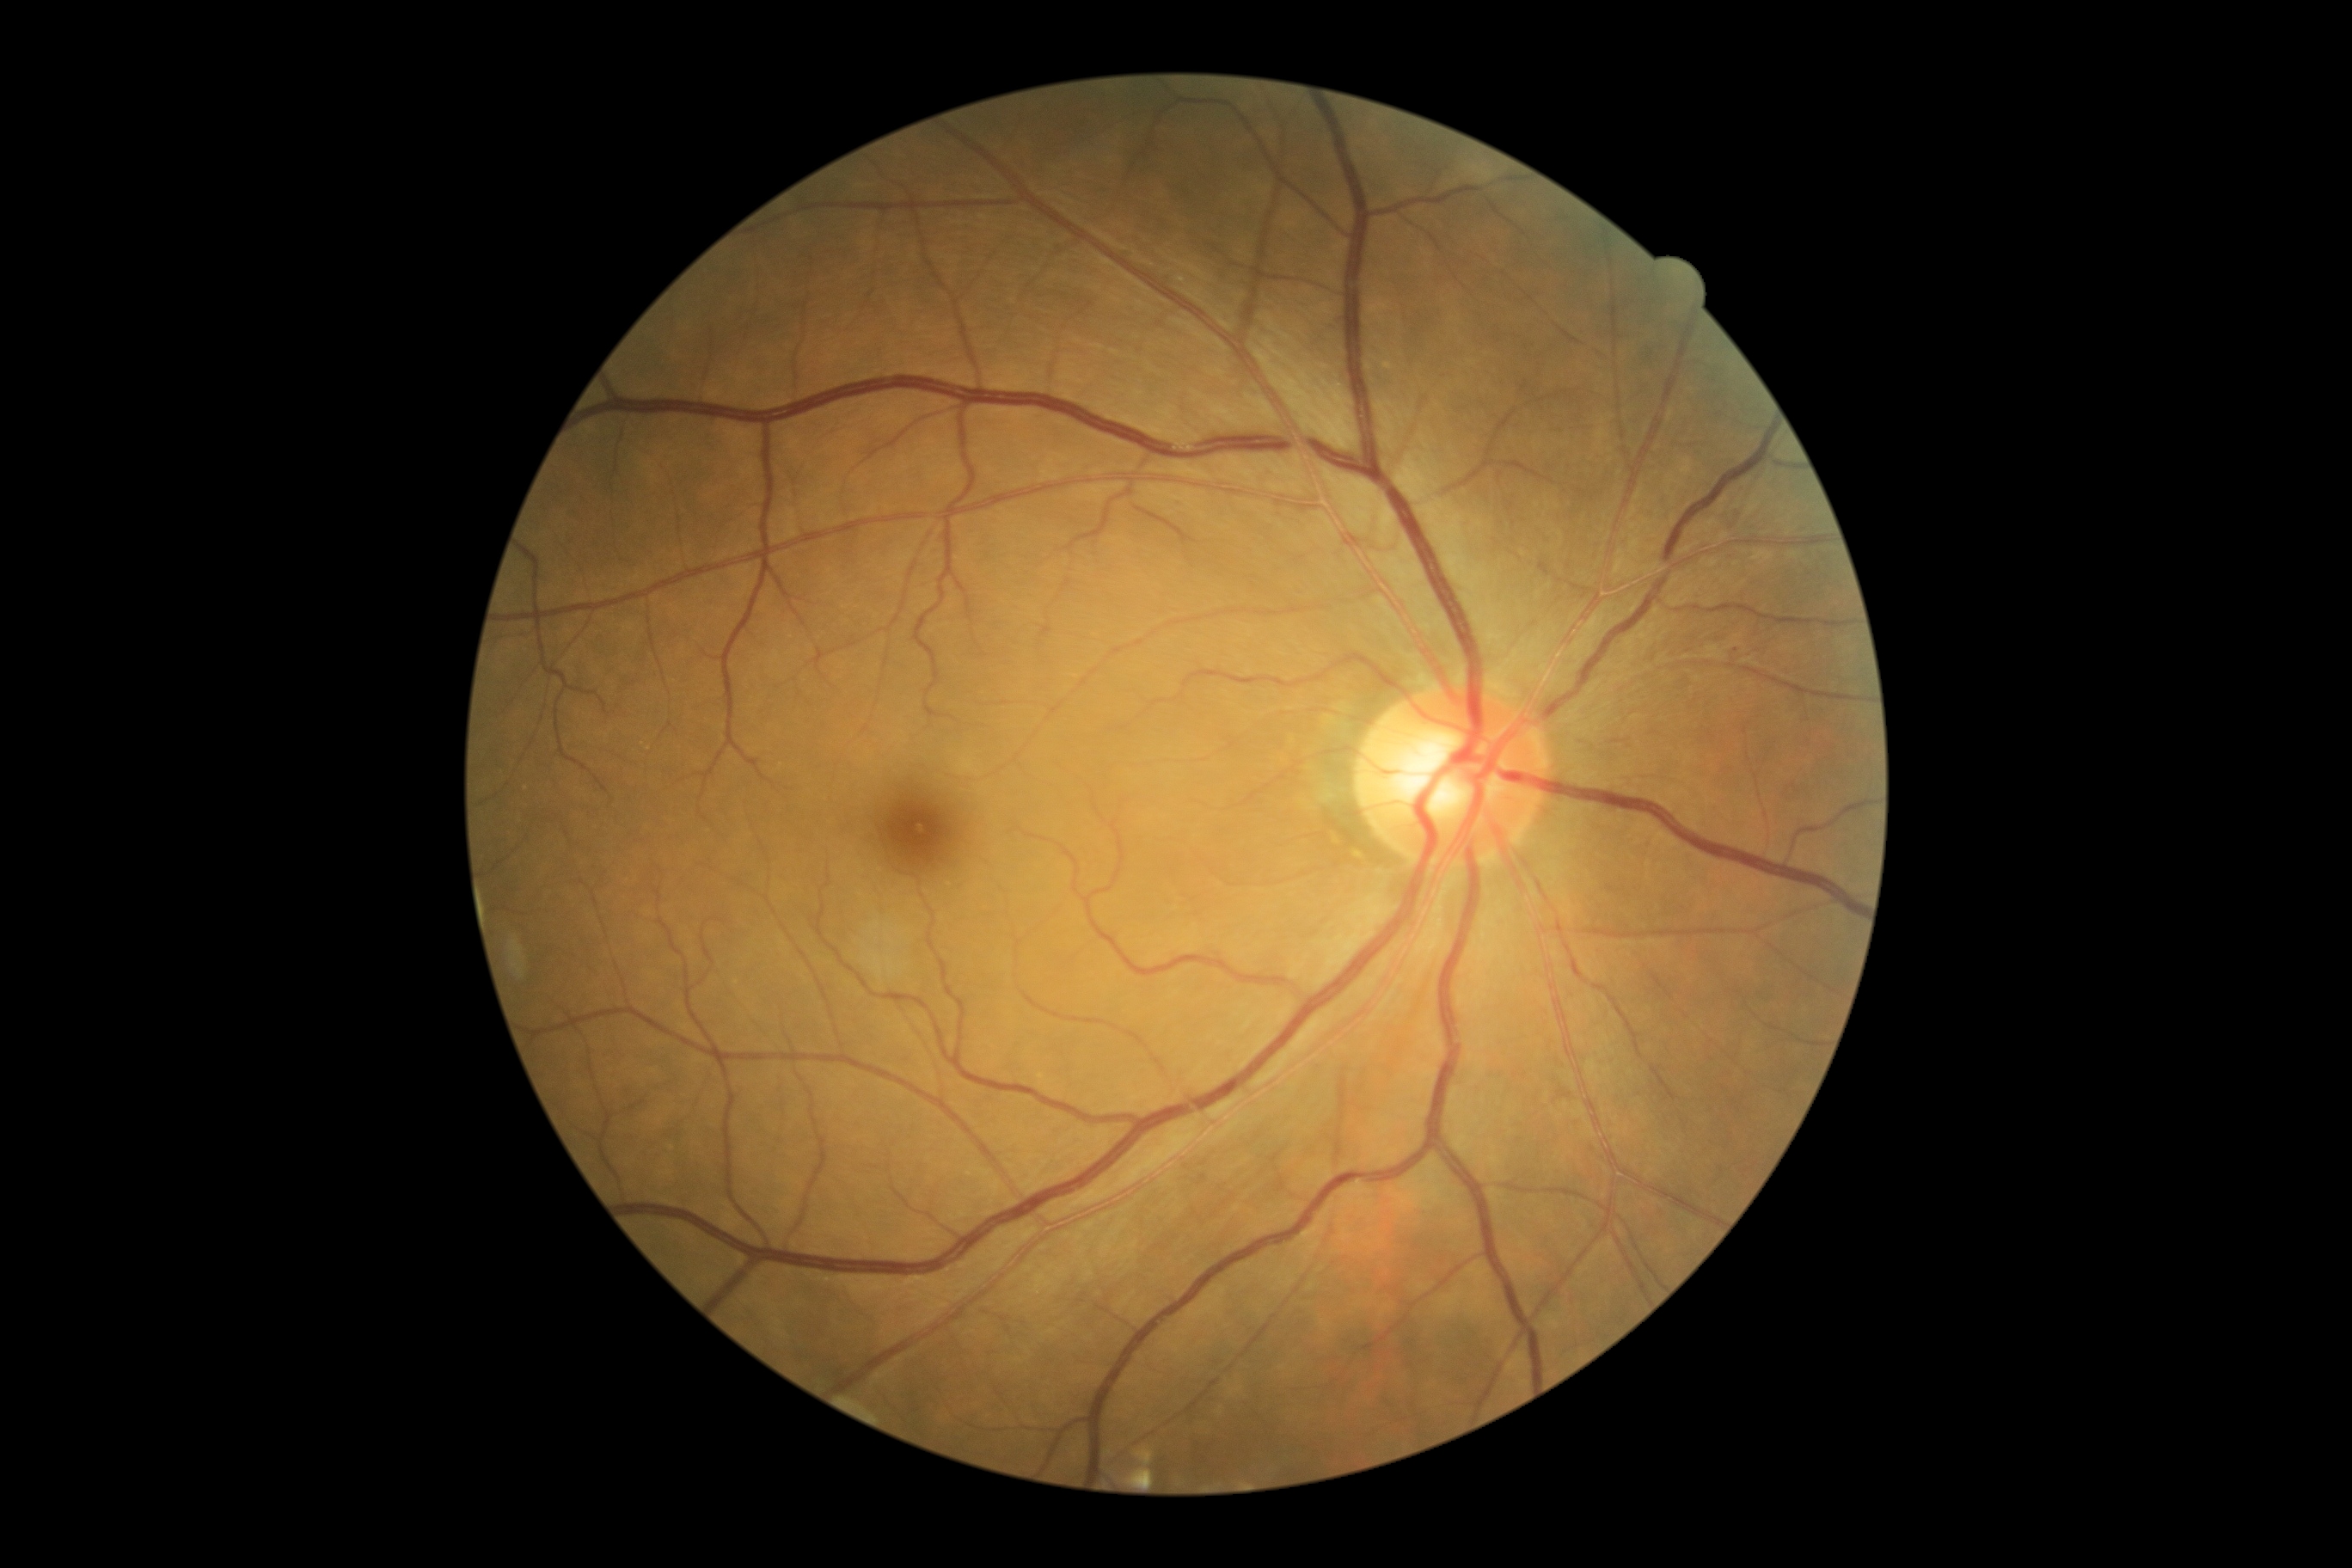
DR grade is 1 (mild NPDR) — presence of microaneurysms only.